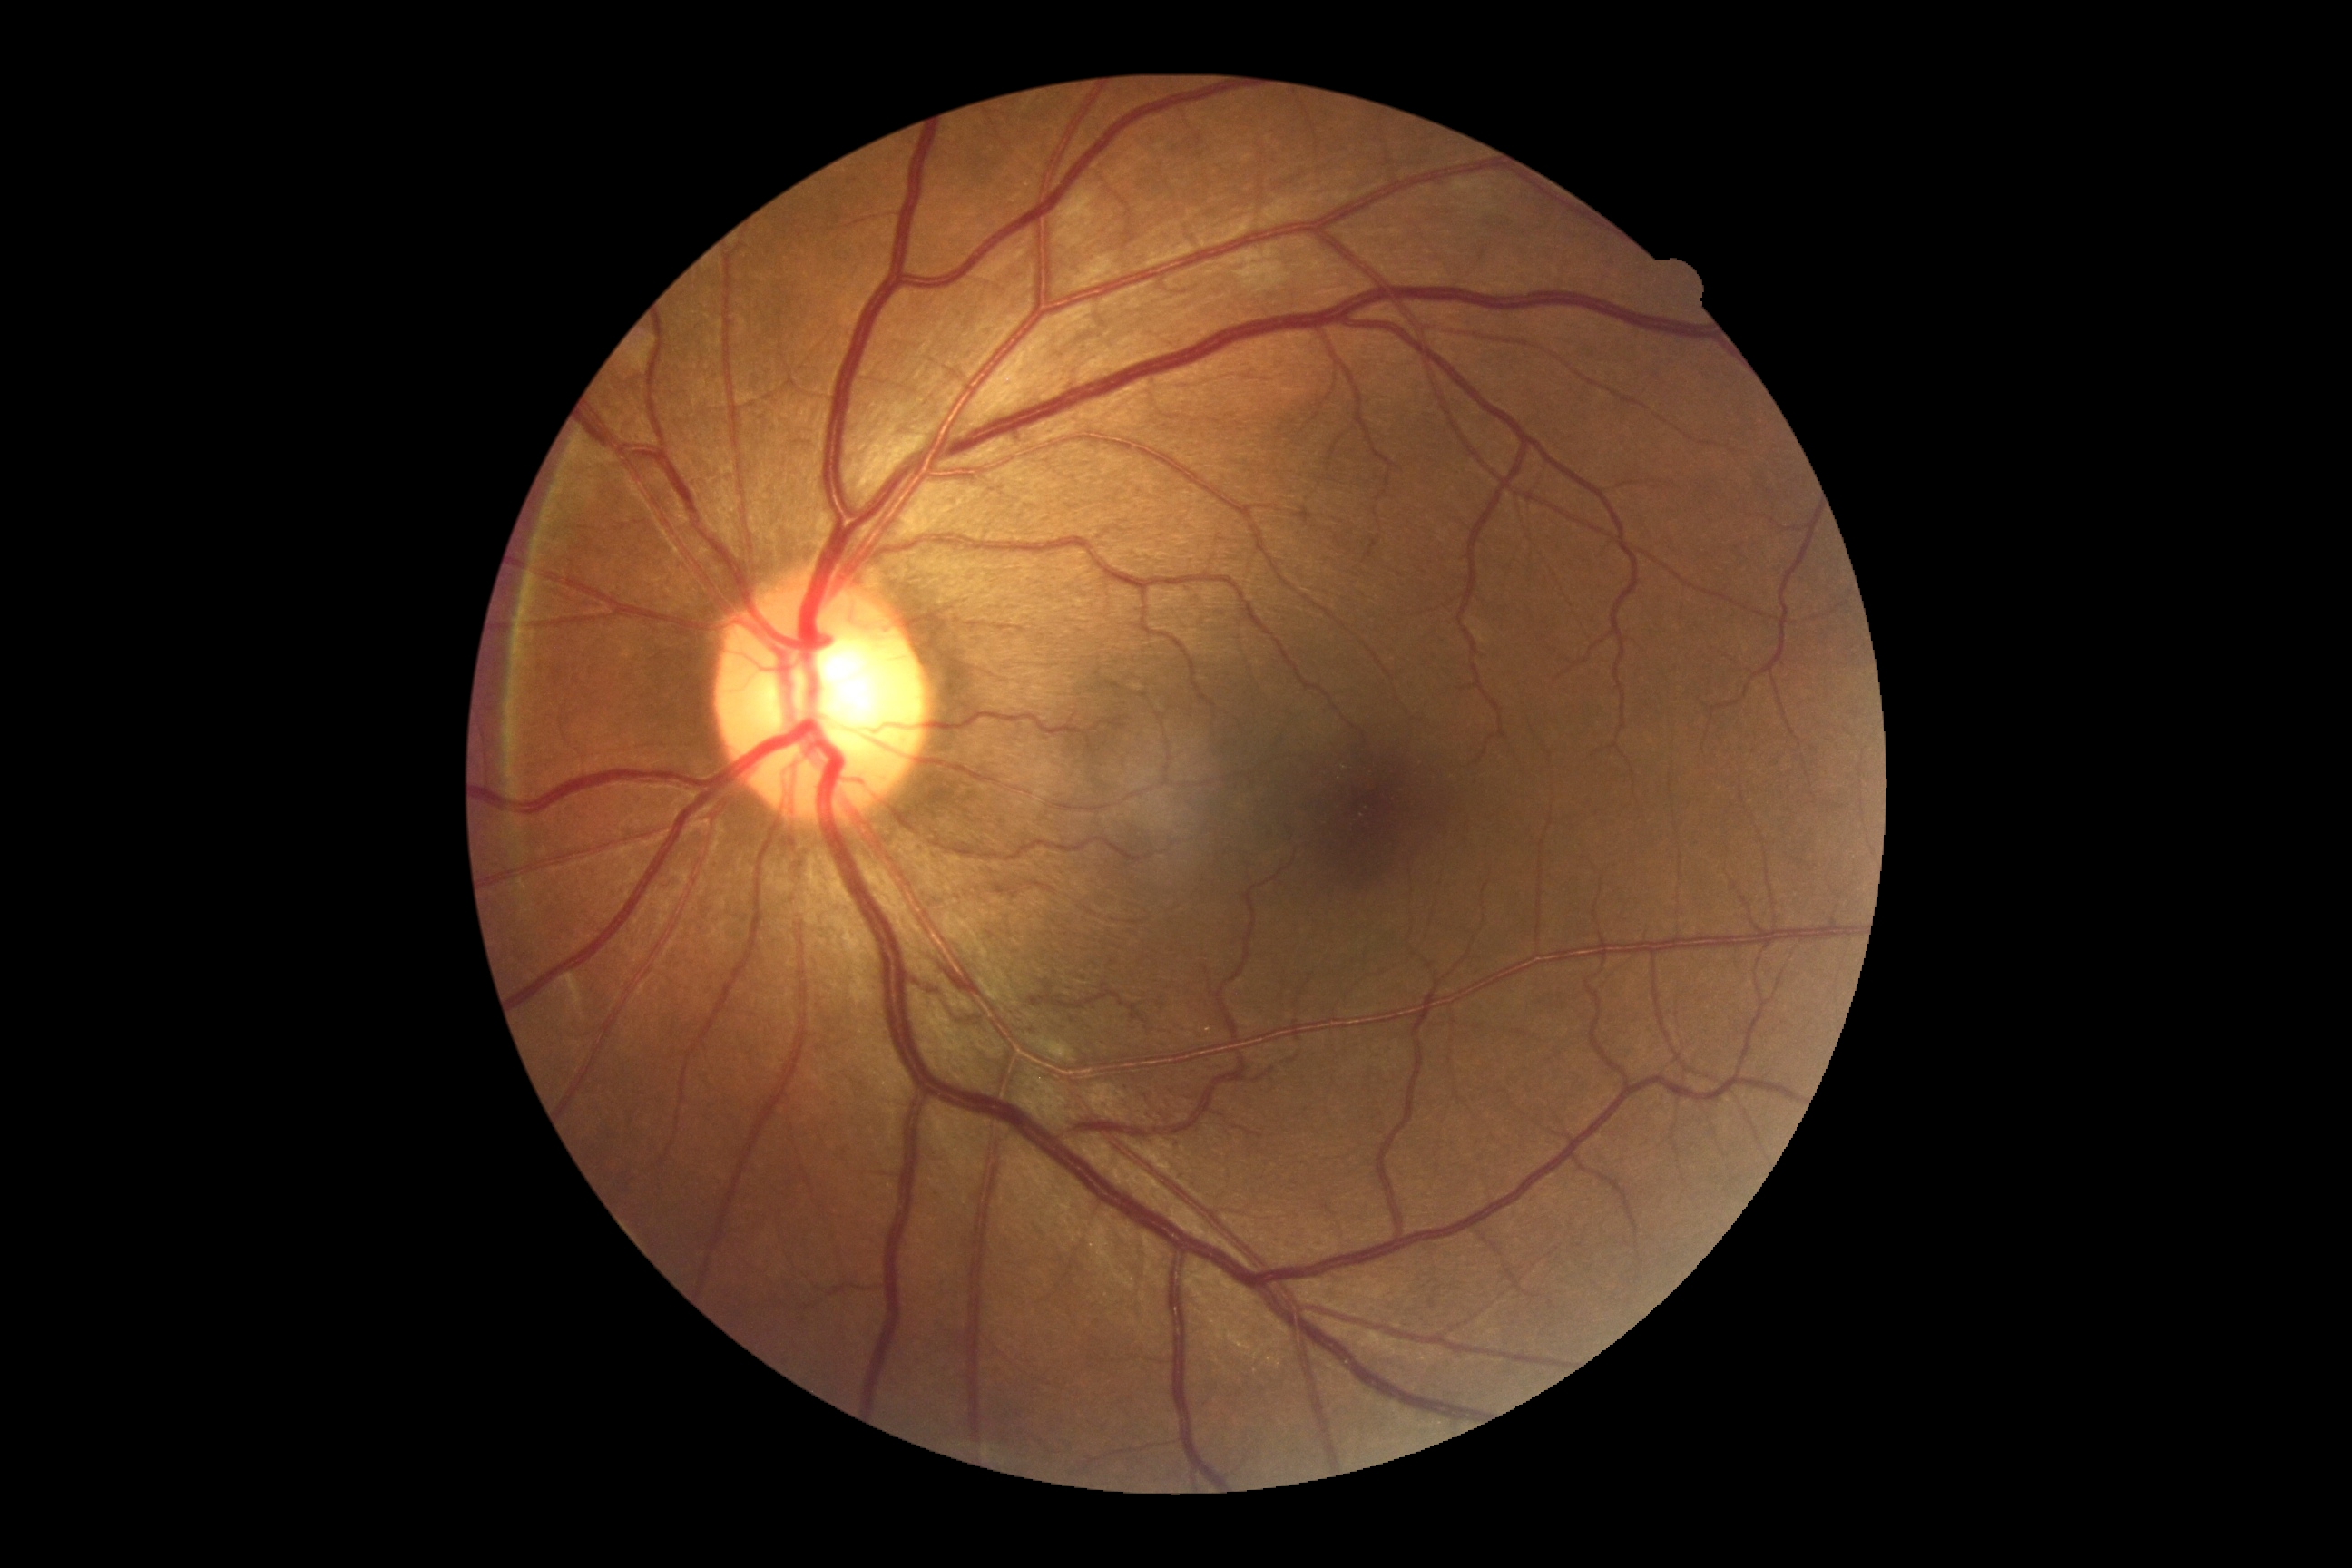
No diabetic retinal disease findings.
Retinopathy grade is no apparent retinopathy (0).